CFP
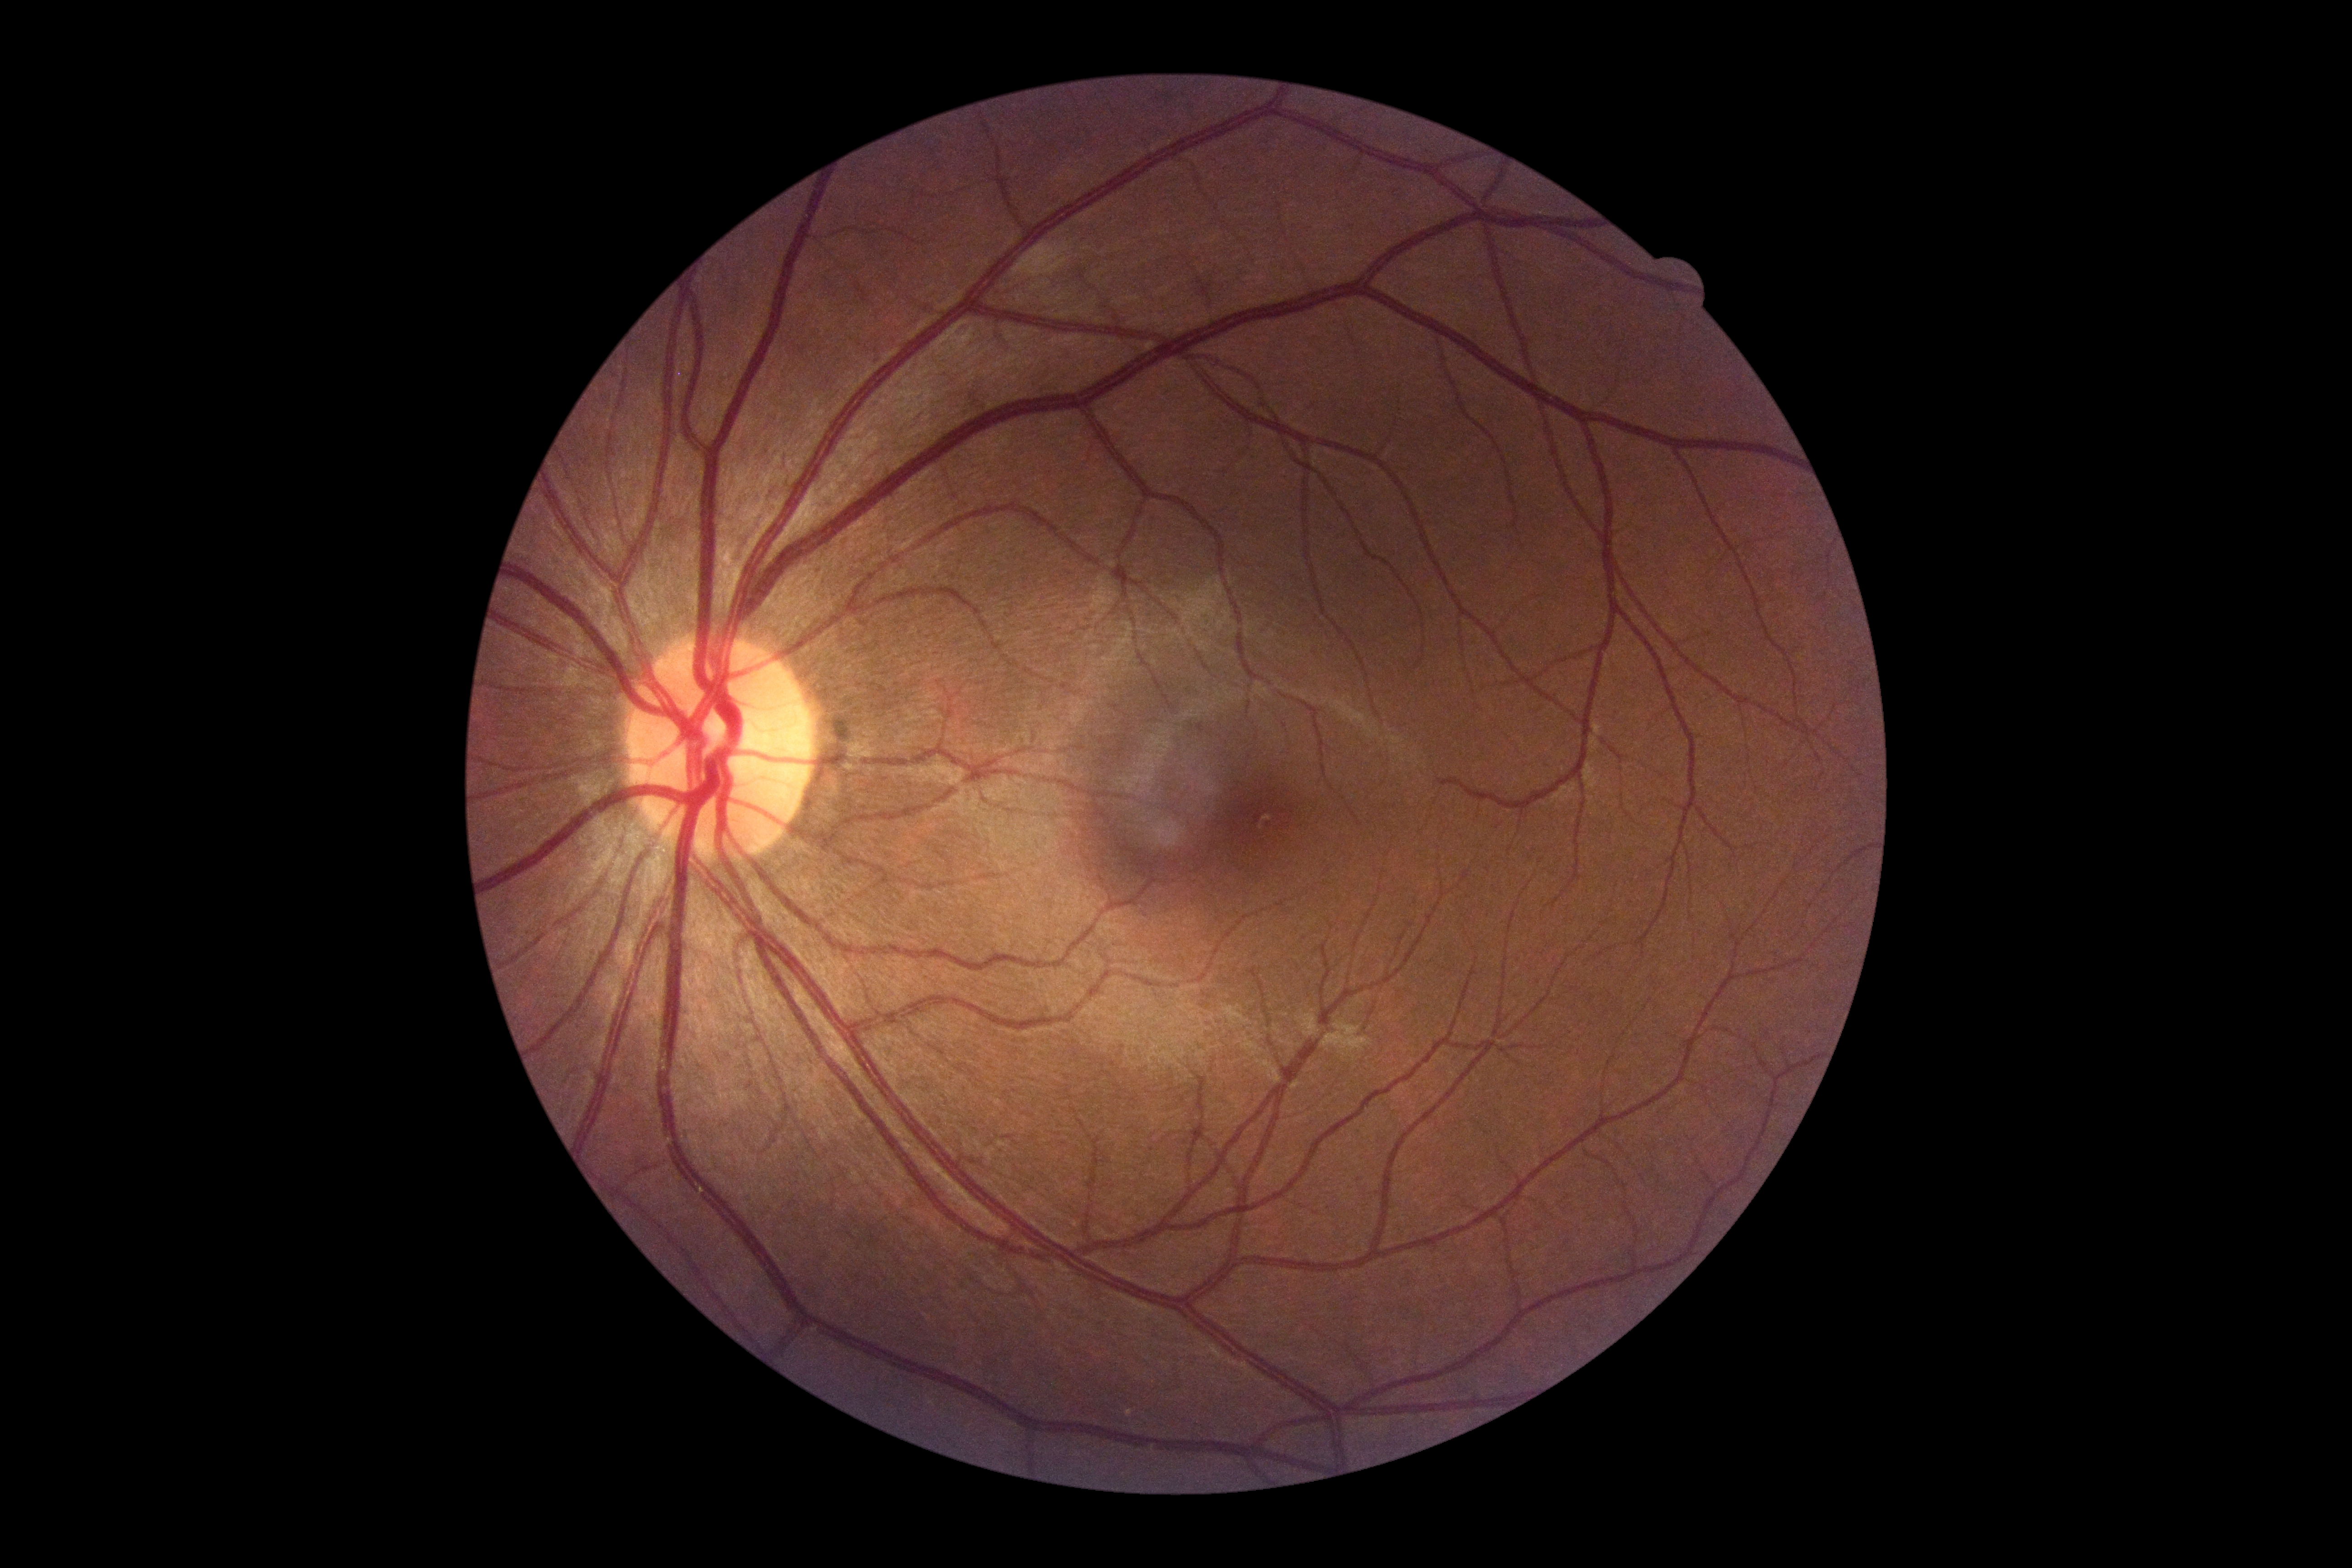

DR severity: grade 0 (no apparent retinopathy).